No pharmacologic dilation; diabetic retinopathy graded by the modified Davis classification
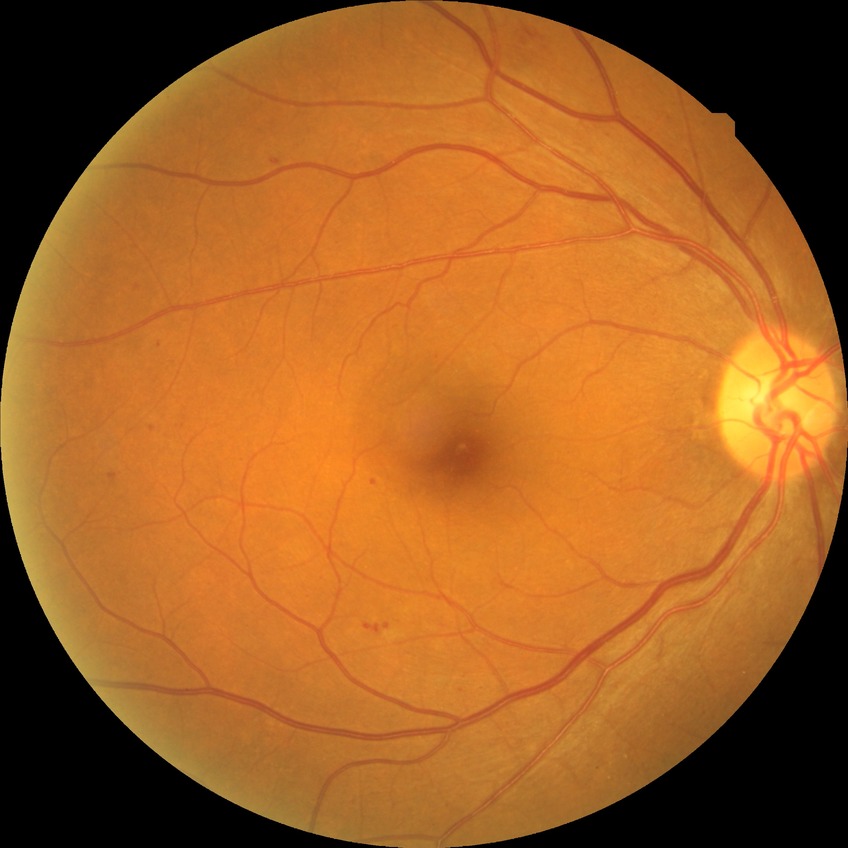
DR class: non-proliferative diabetic retinopathy.
Davis grading is pre-proliferative diabetic retinopathy.